Retinal fundus photograph: 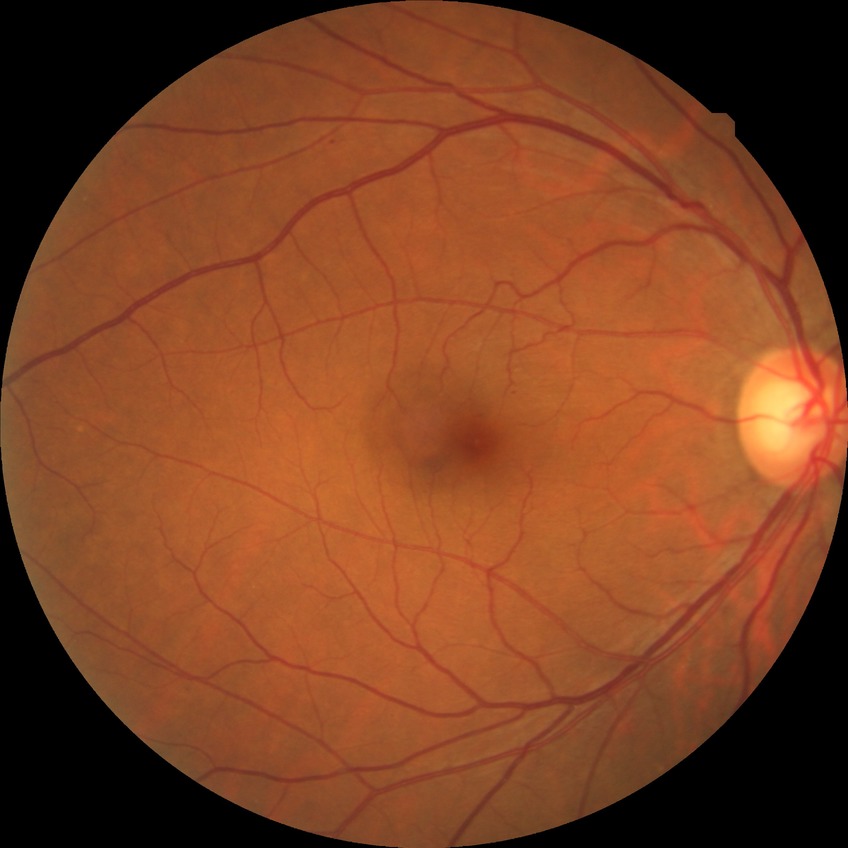
Modified Davis grading: no diabetic retinopathy.